130° field of view (Natus RetCam Envision) · wide-field fundus image from infant ROP screening — 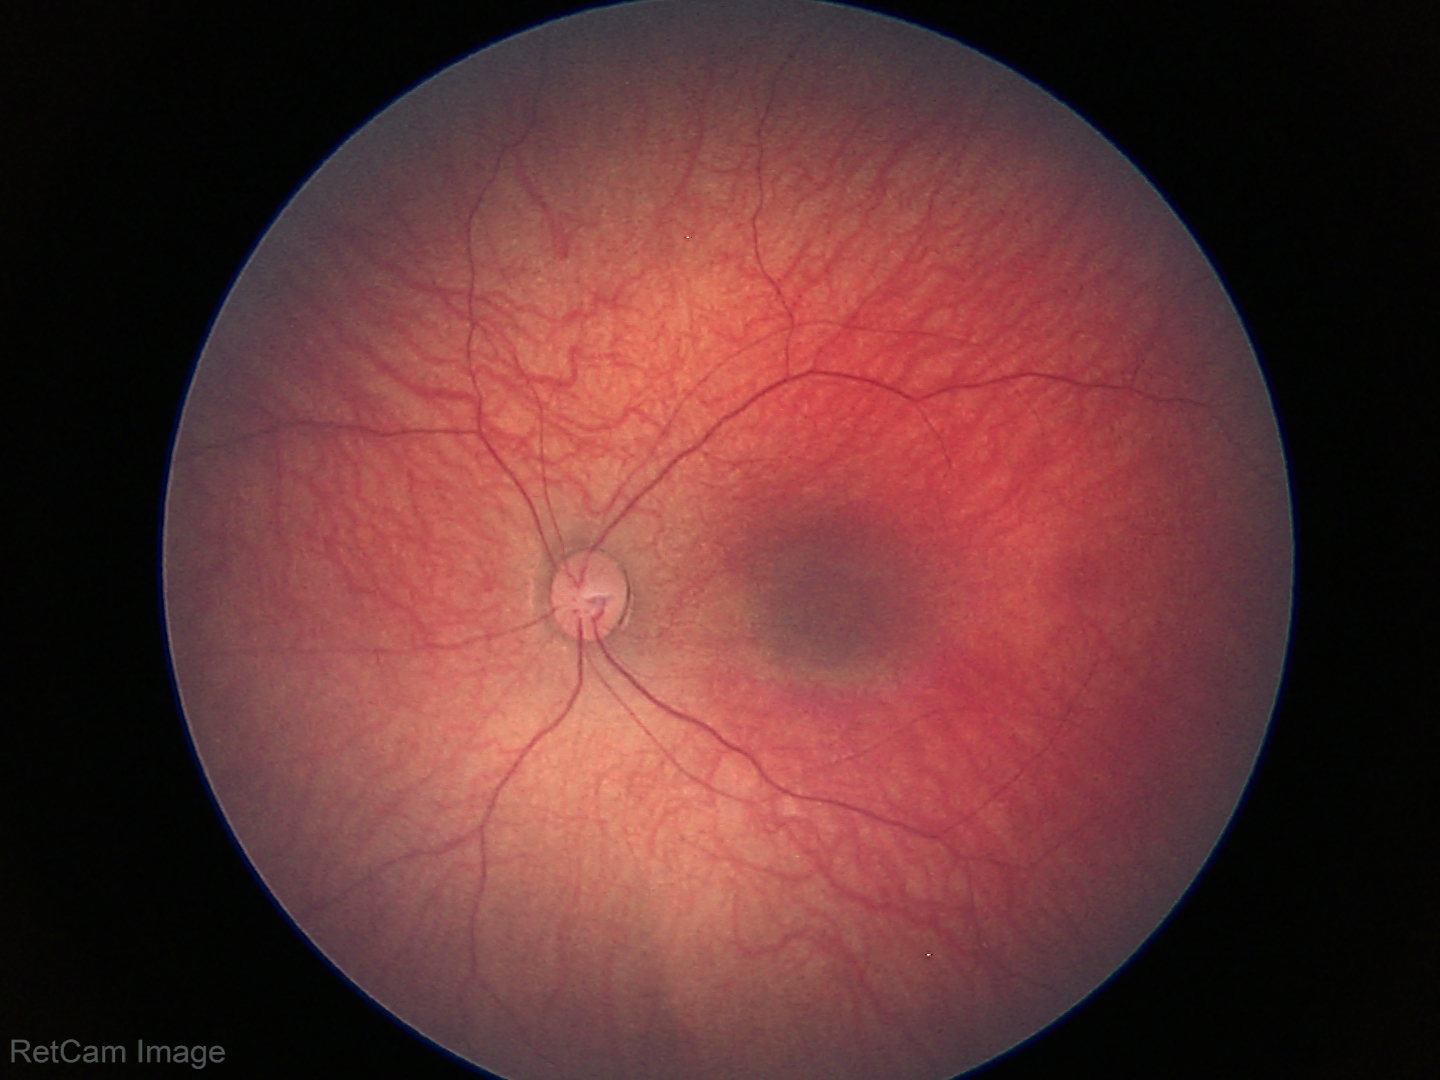

Screening examination diagnosed as physiological.